Pediatric retinal photograph (wide-field) · 130° field of view (Natus RetCam Envision) · 1440x1080
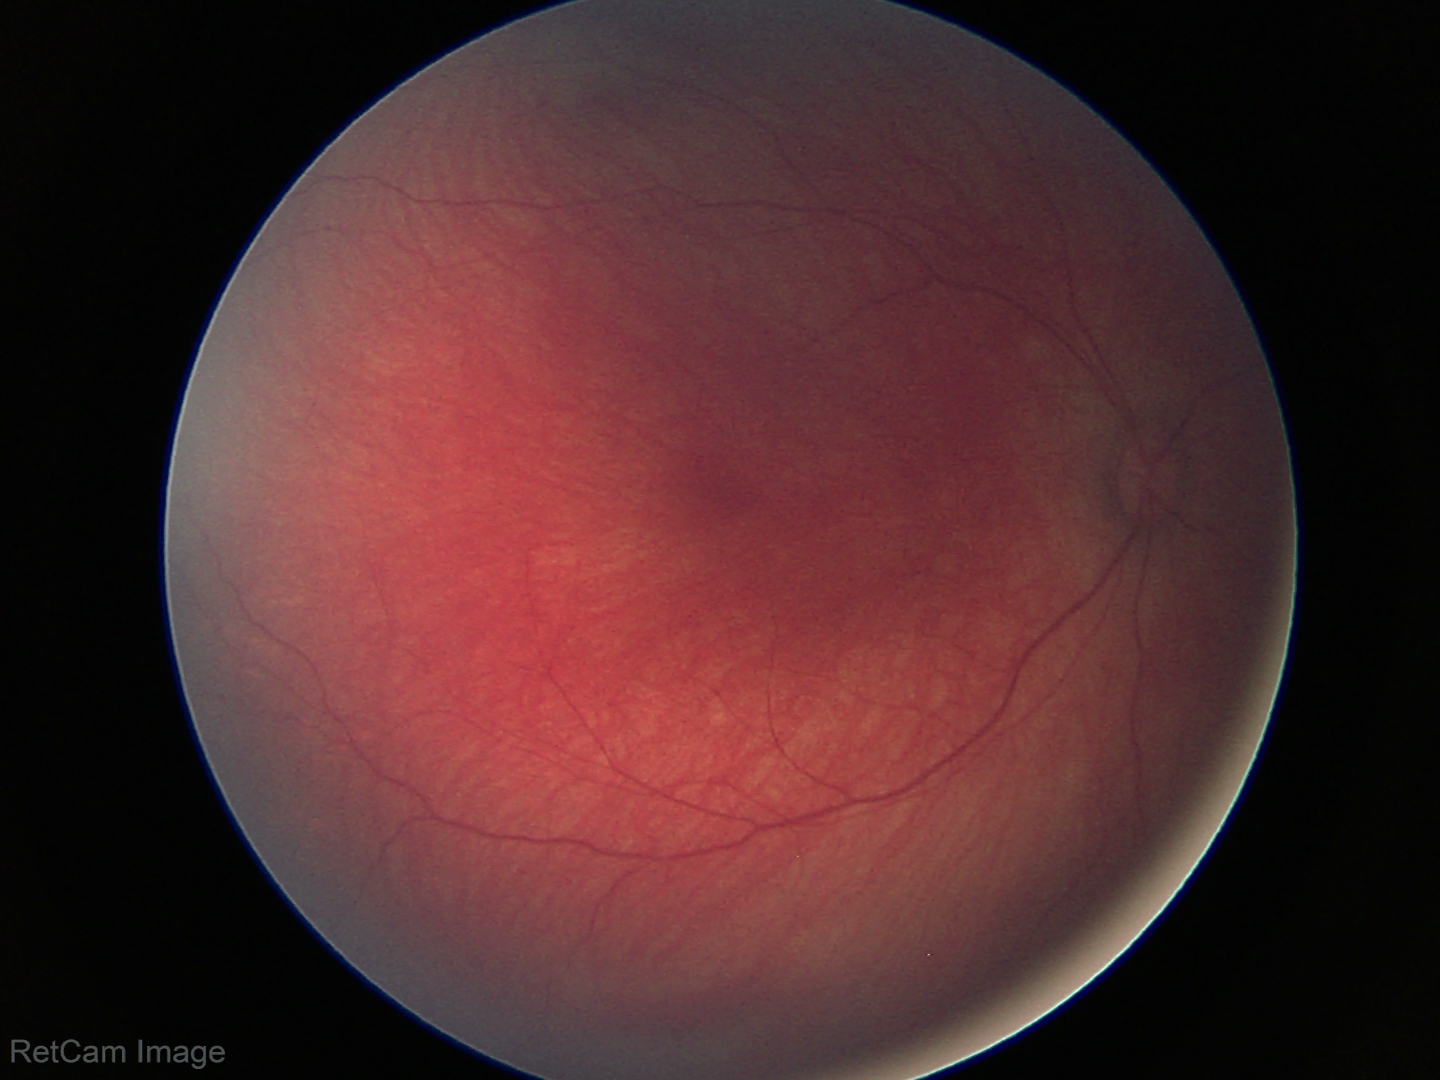 Examination with physiological retinal findings.